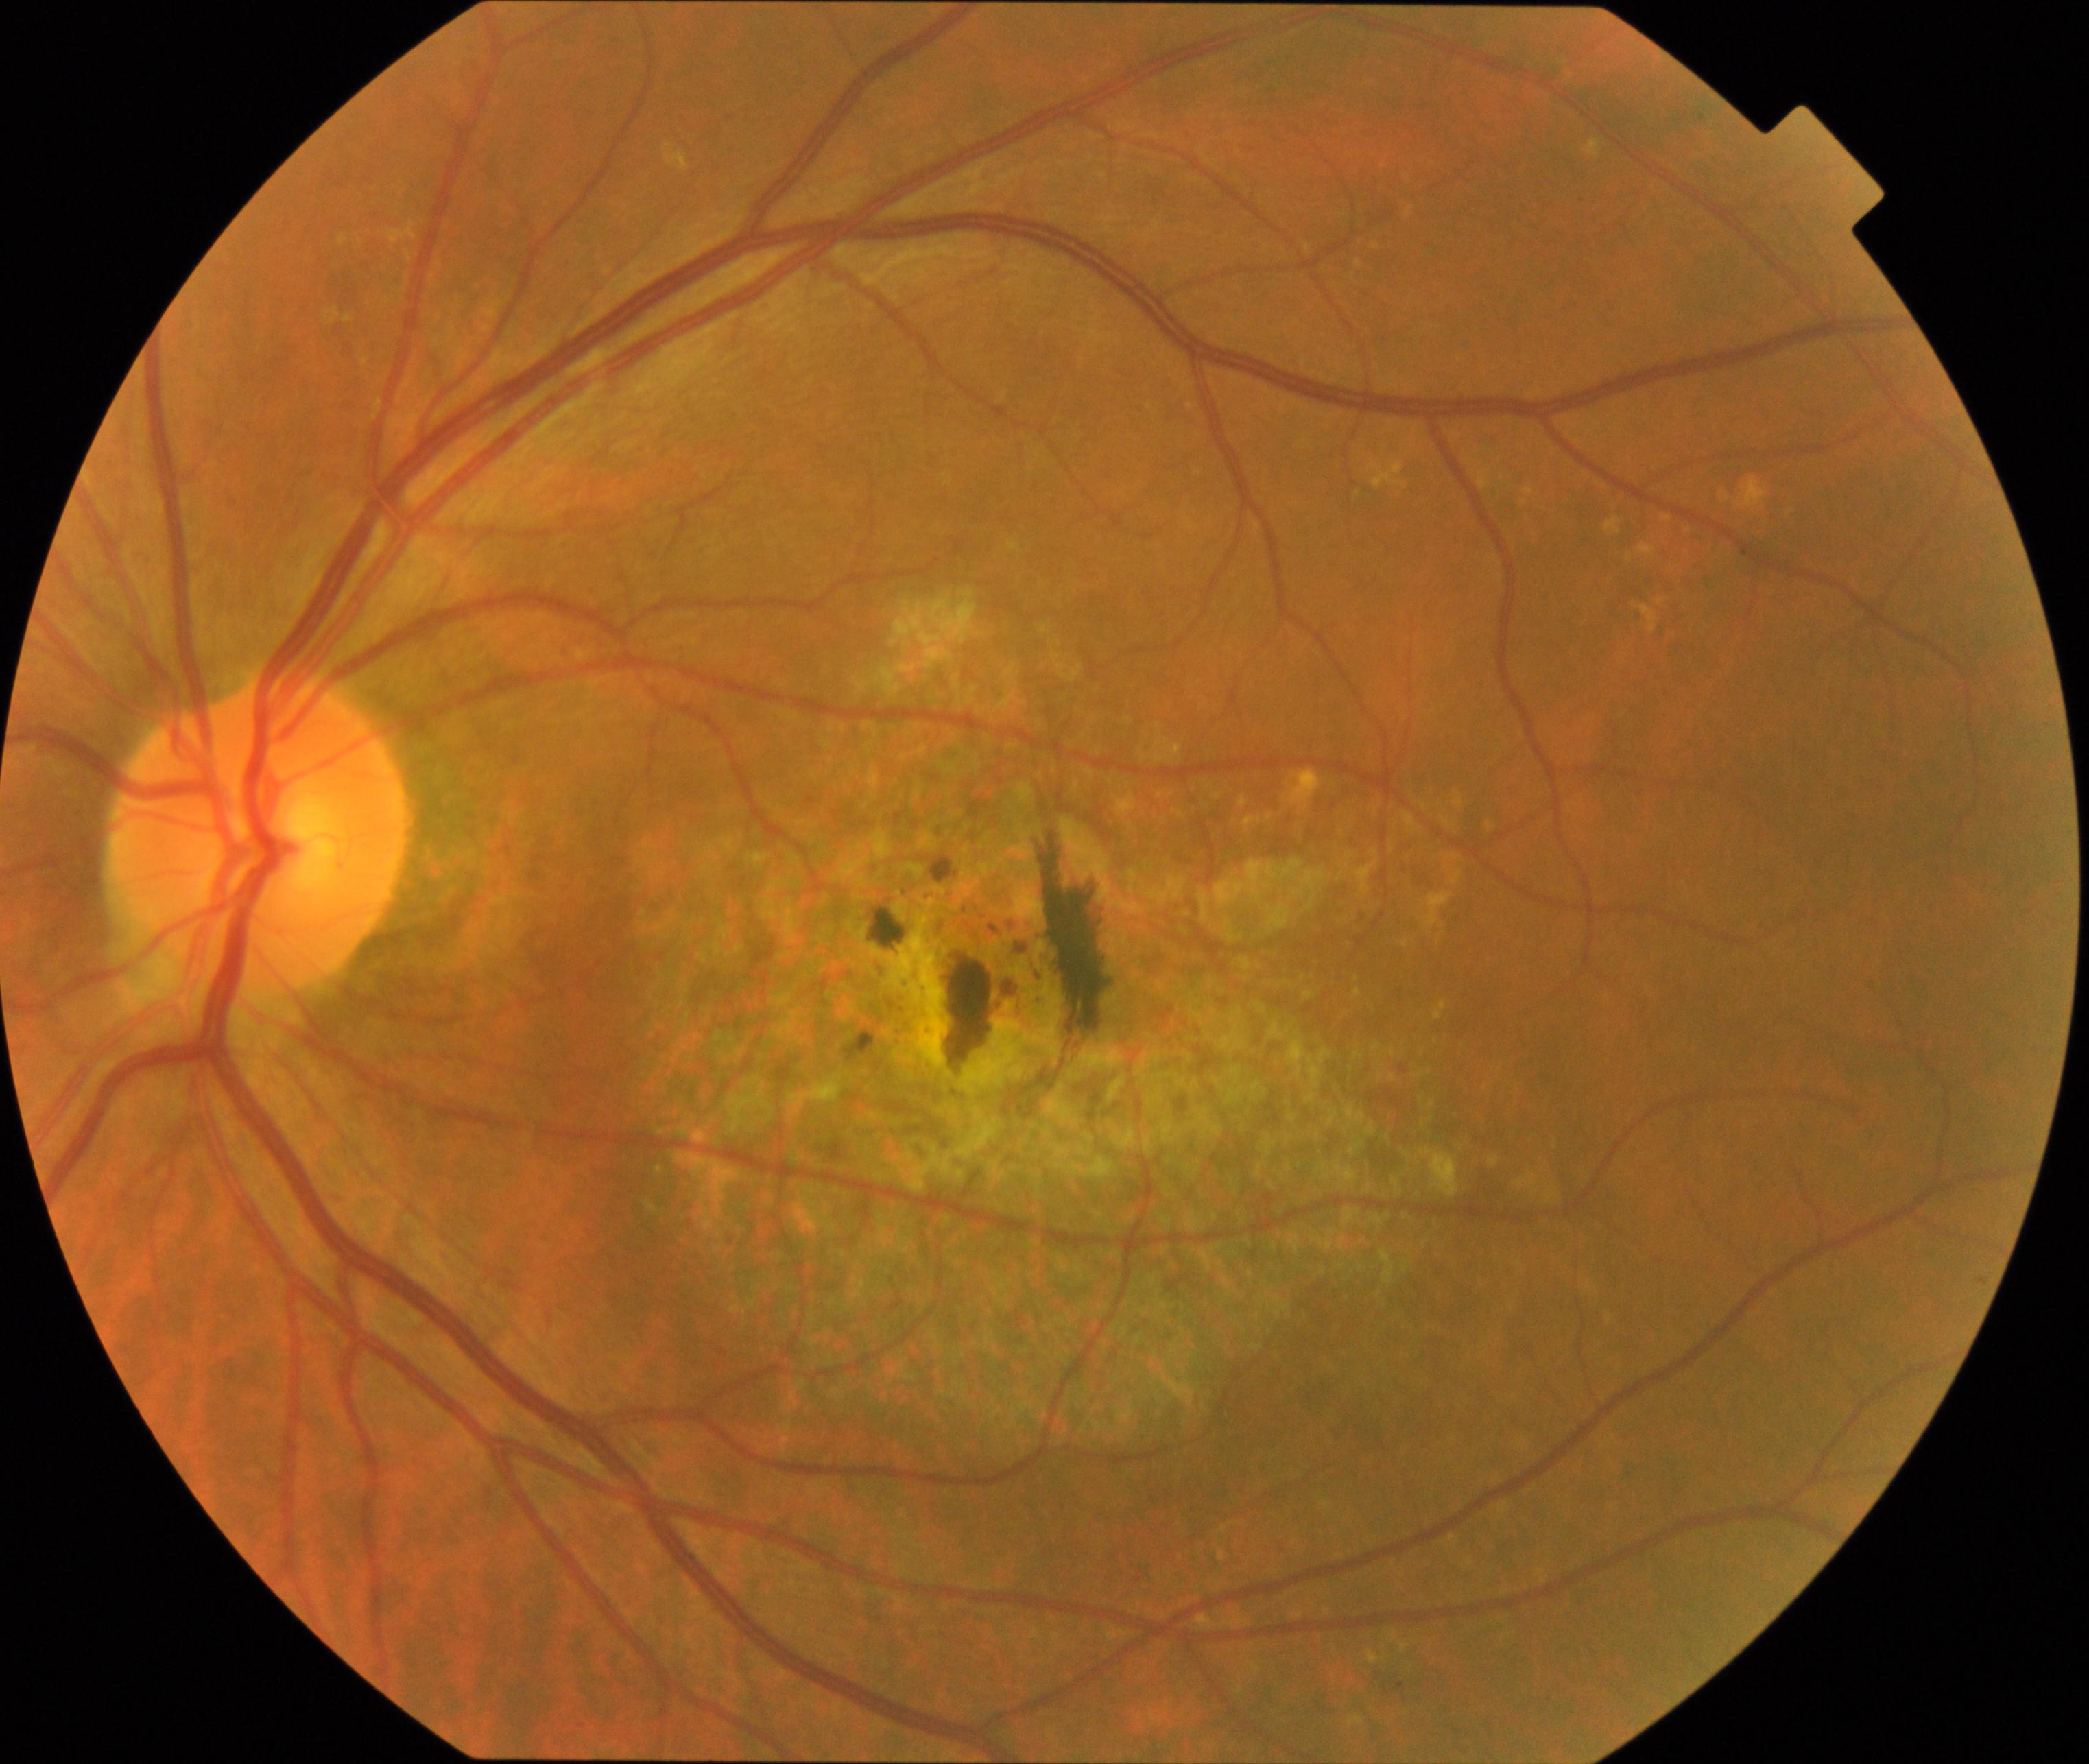

Color fundus photograph showing maculopathy.